Camera: Clarity RetCam 3 (130° FOV). Wide-field fundus image from infant ROP screening:
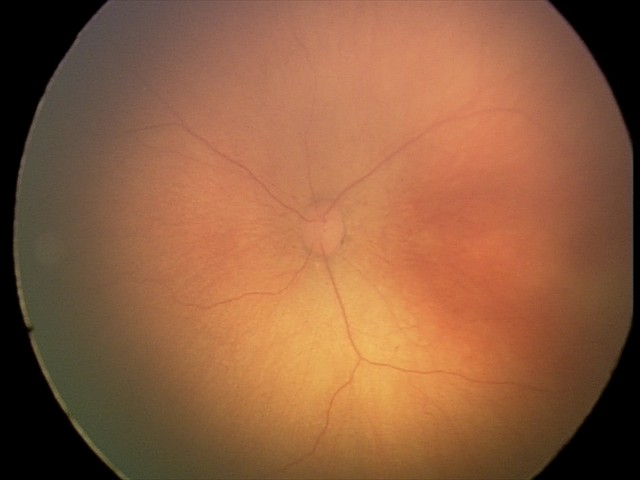
Retinopathy of prematurity (ROP) stage = 0
plus form = absent